CFP.
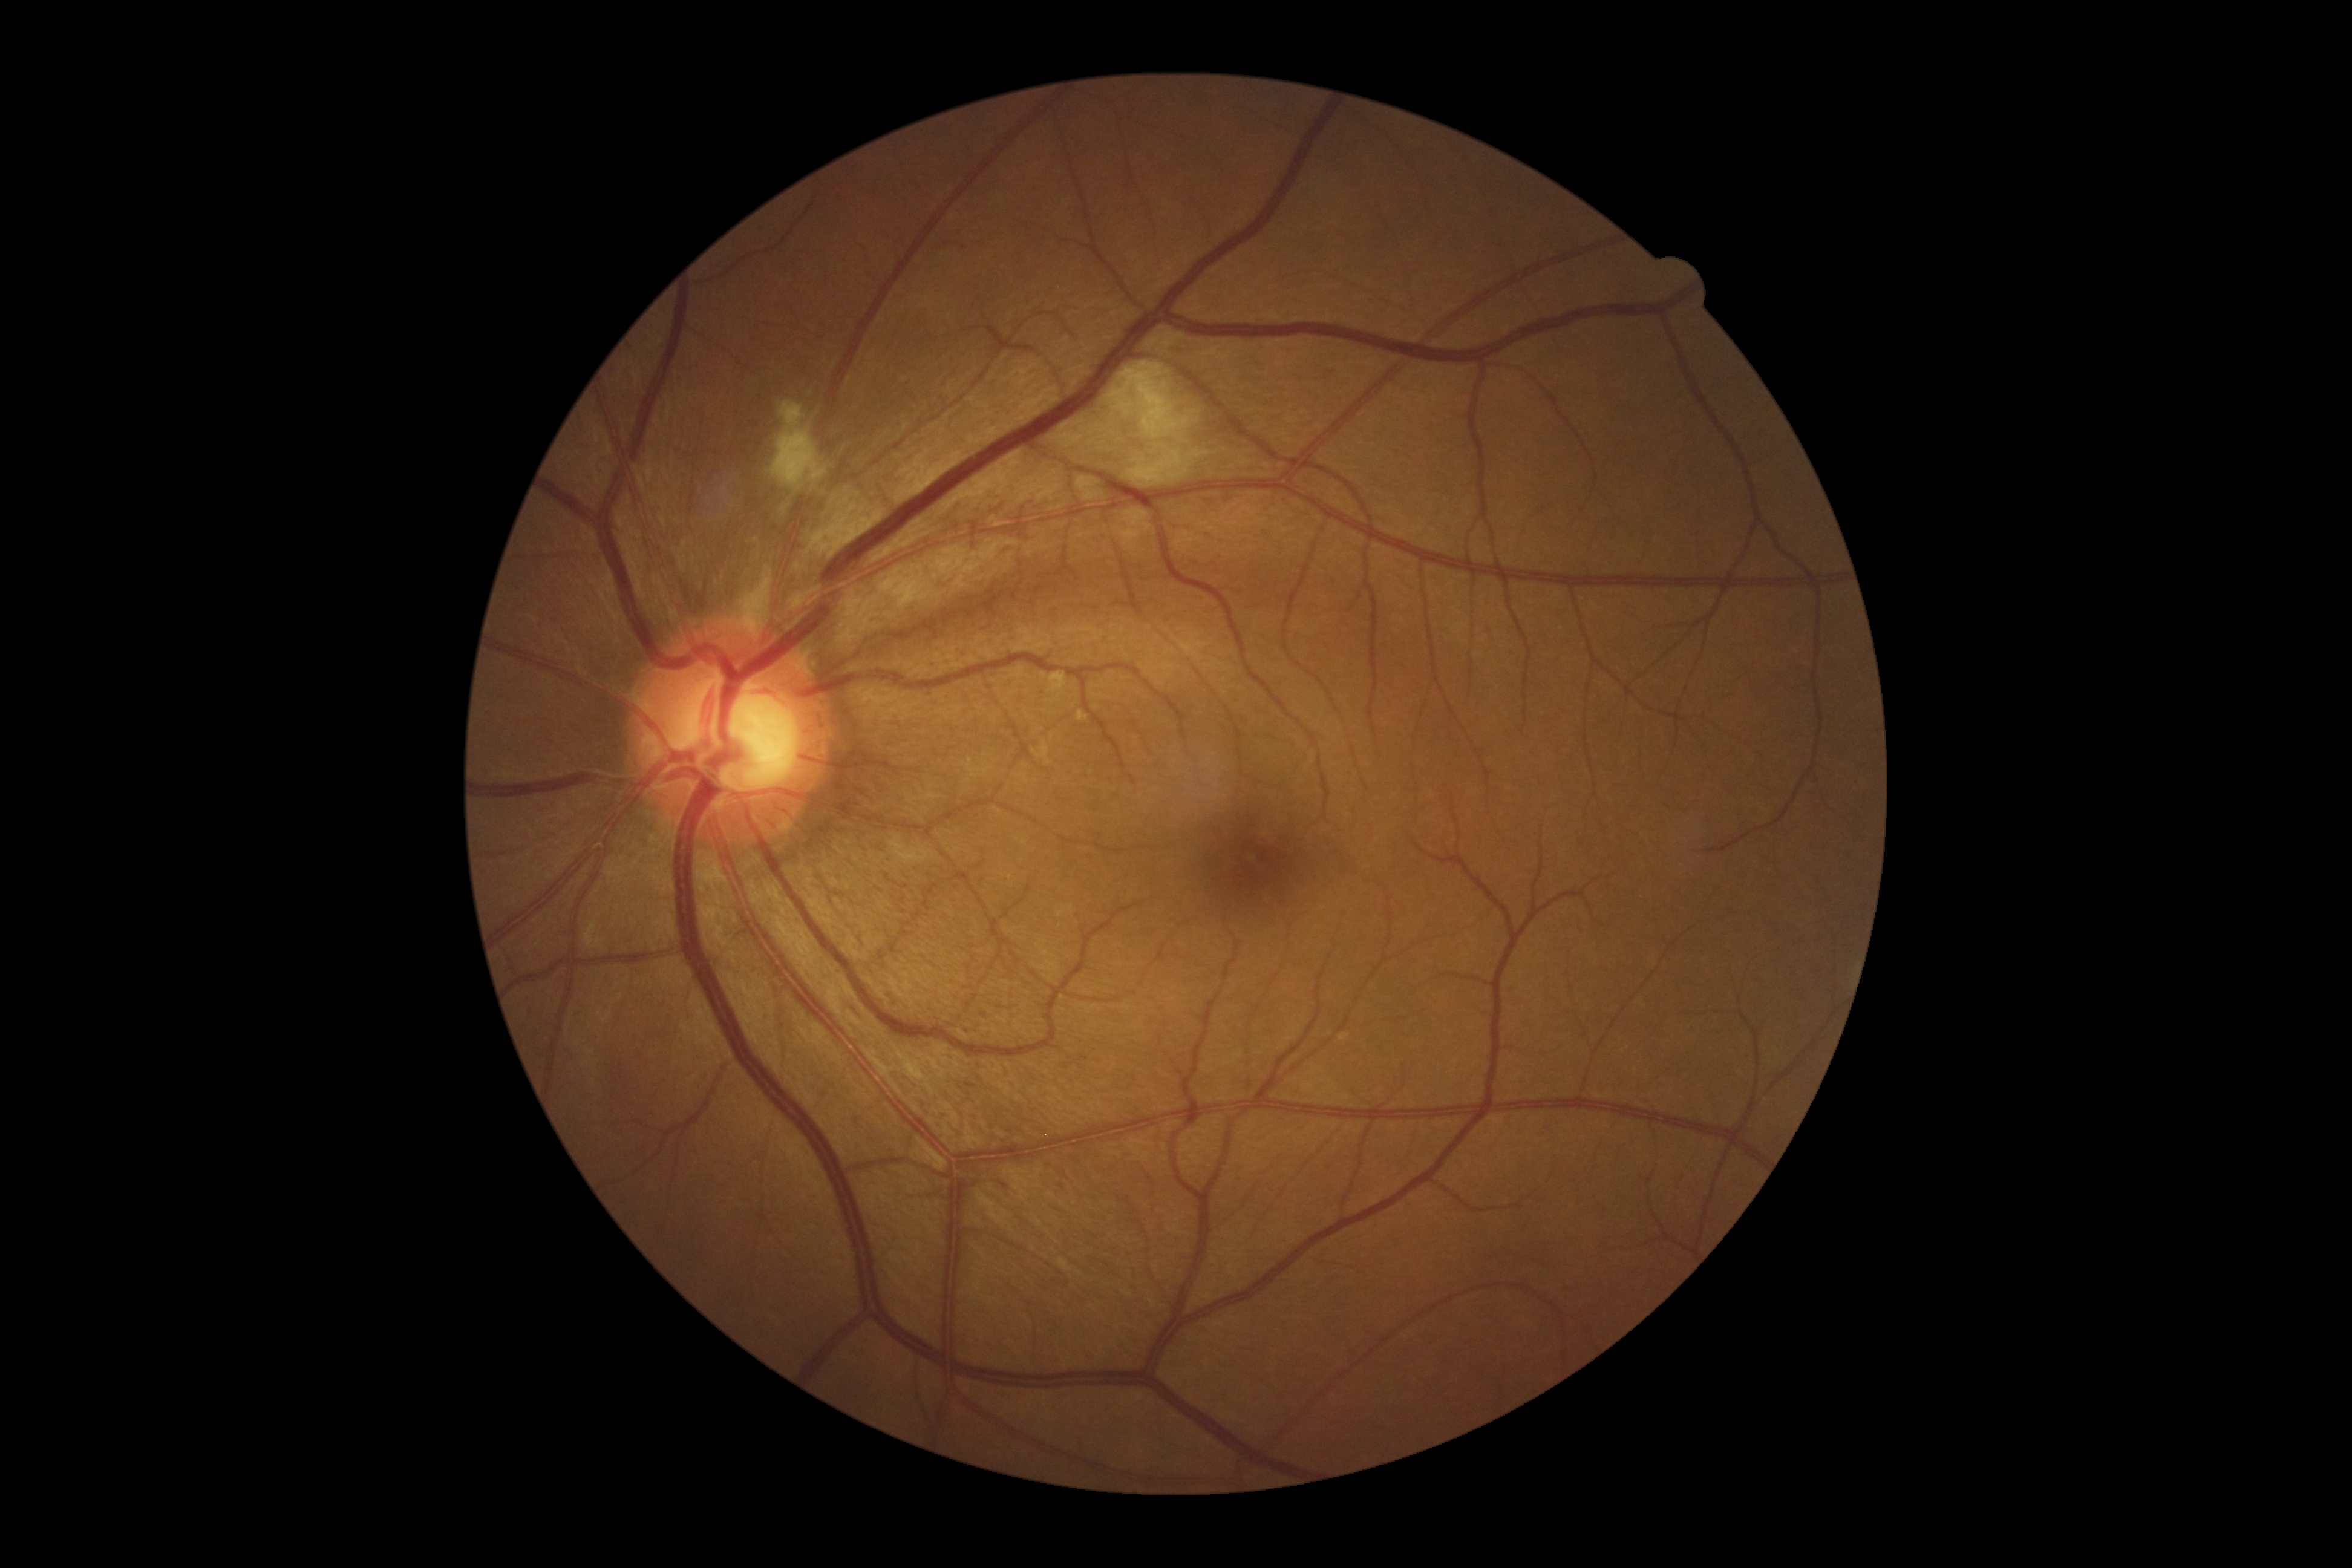
DR=grade 2; DR class=non-proliferative diabetic retinopathy.